CFP: 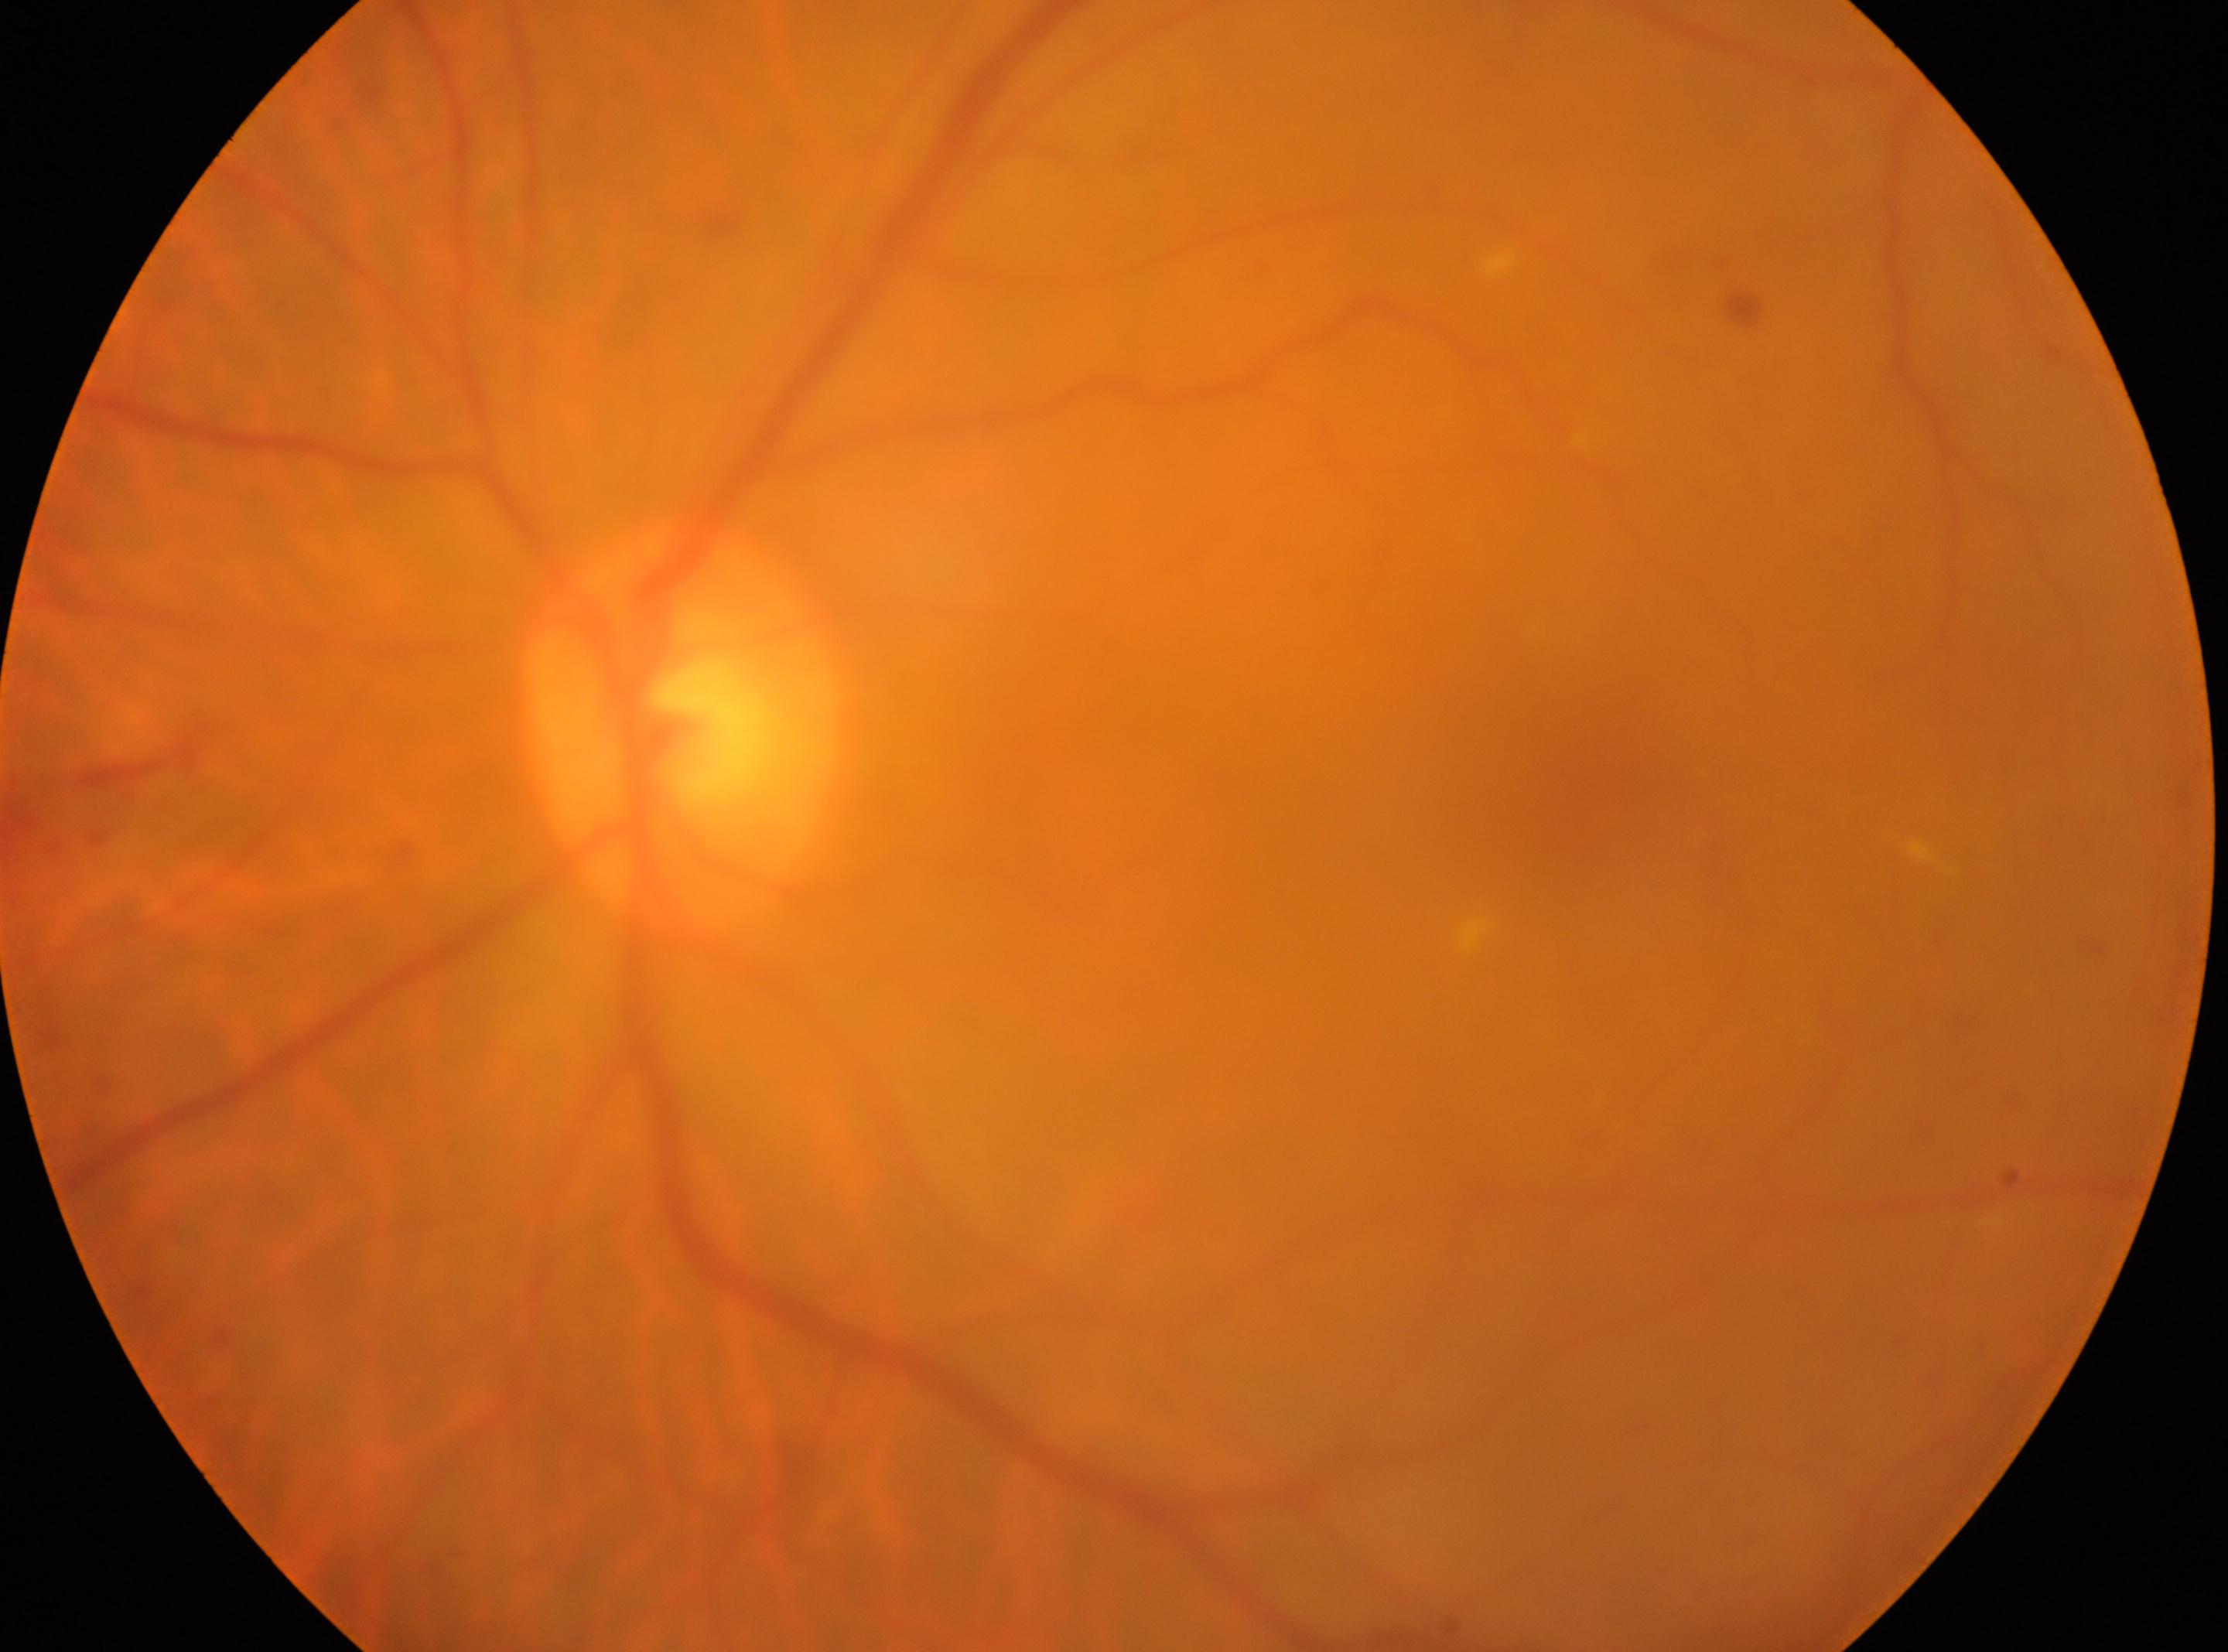

Optic disc center: 681, 726.
Retinopathy grade: 2.
Macular center located at 1583, 781.
The image shows the left eye.